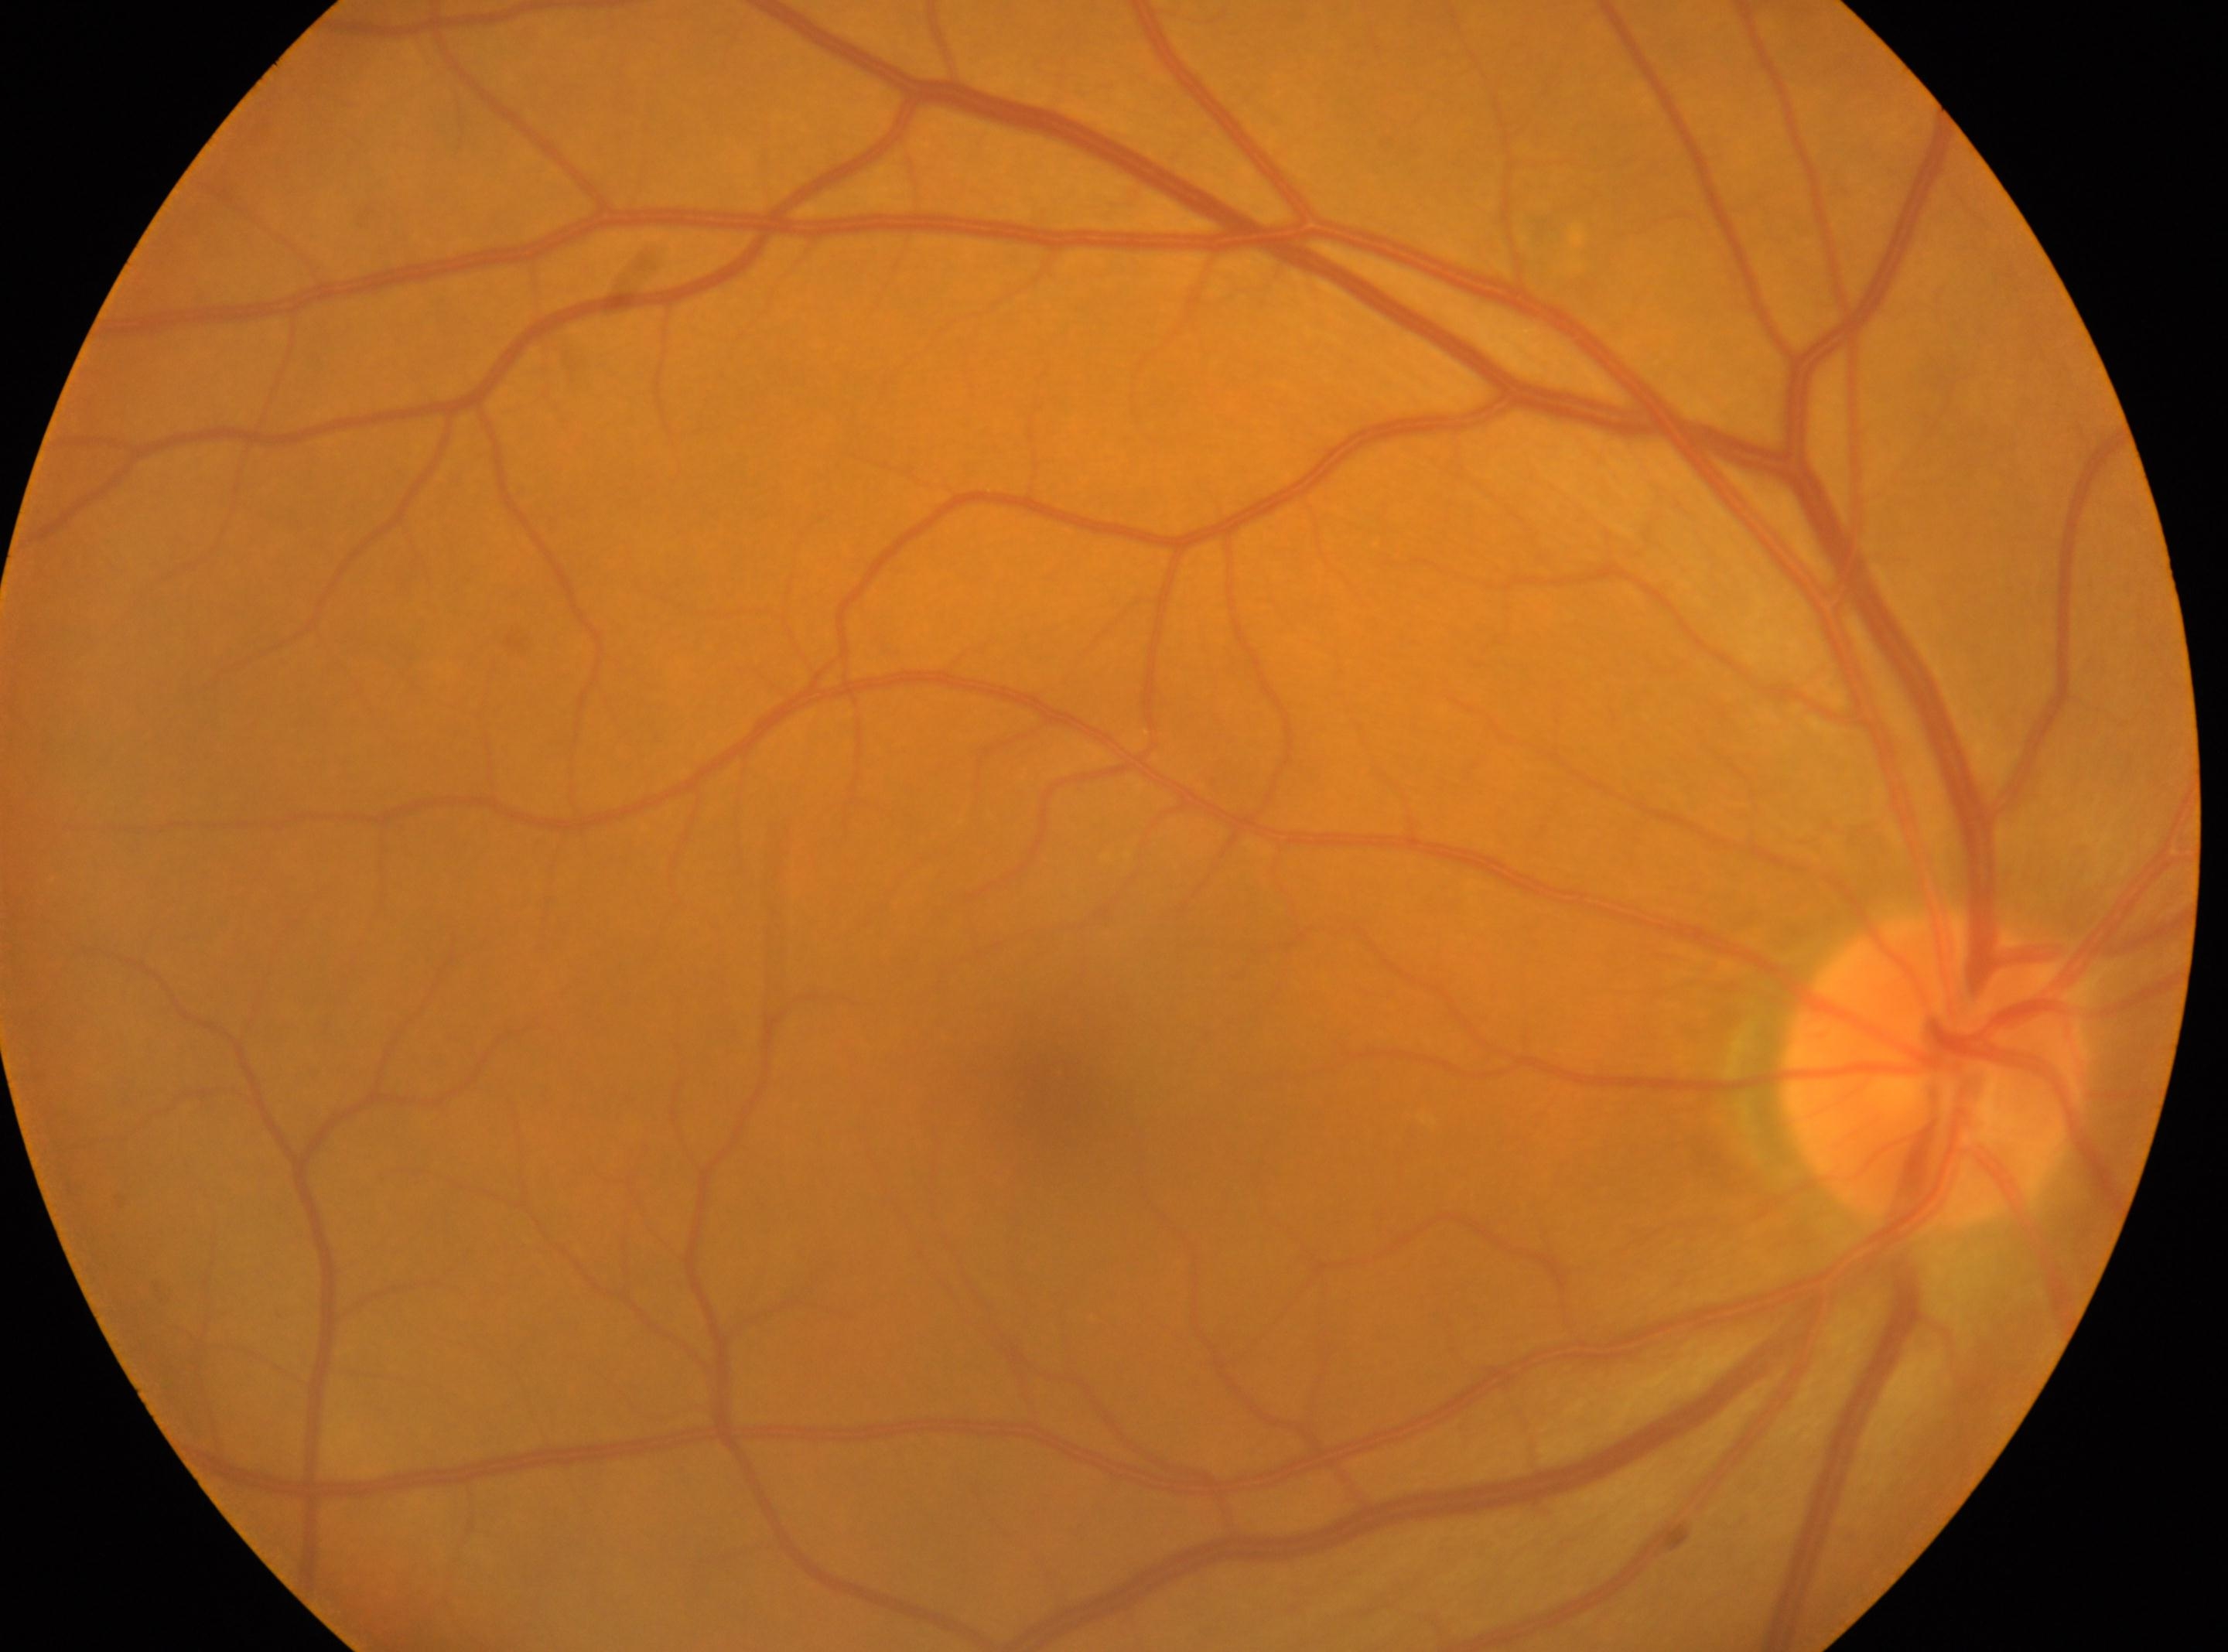

eye: OD | diabetic retinopathy (DR): no apparent retinopathy (grade 0) | macula center: [1051, 1081] | ONH: [1935, 1069] | DR impression: No signs of diabetic retinopathy.